DR severity per modified Davis staging.
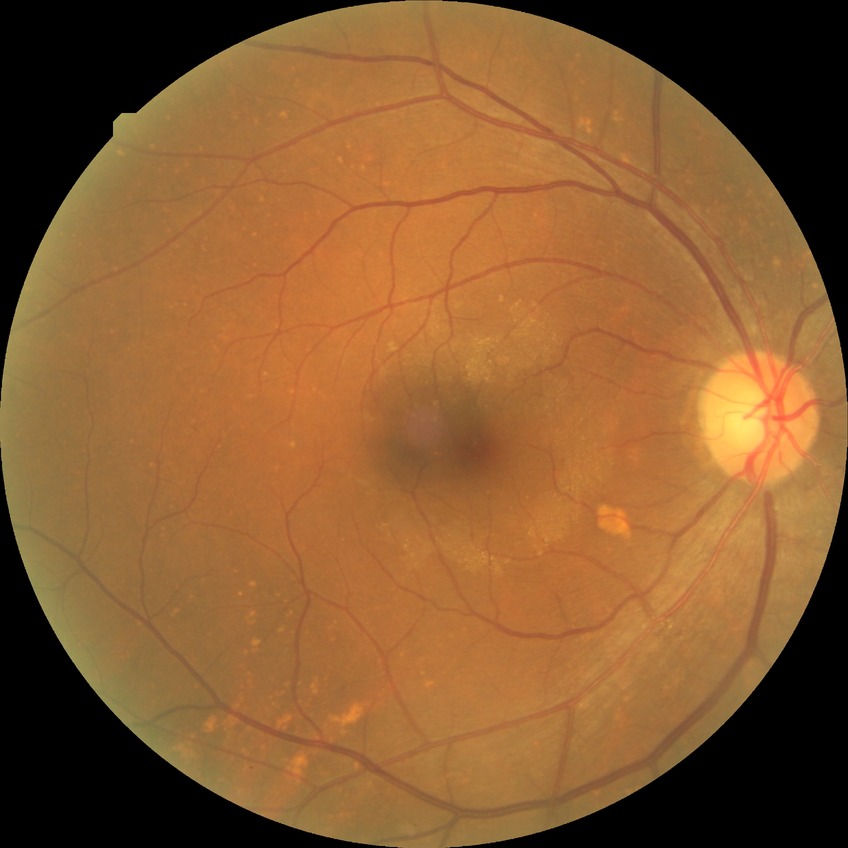 No DR findings.
Davis grade: NDR.